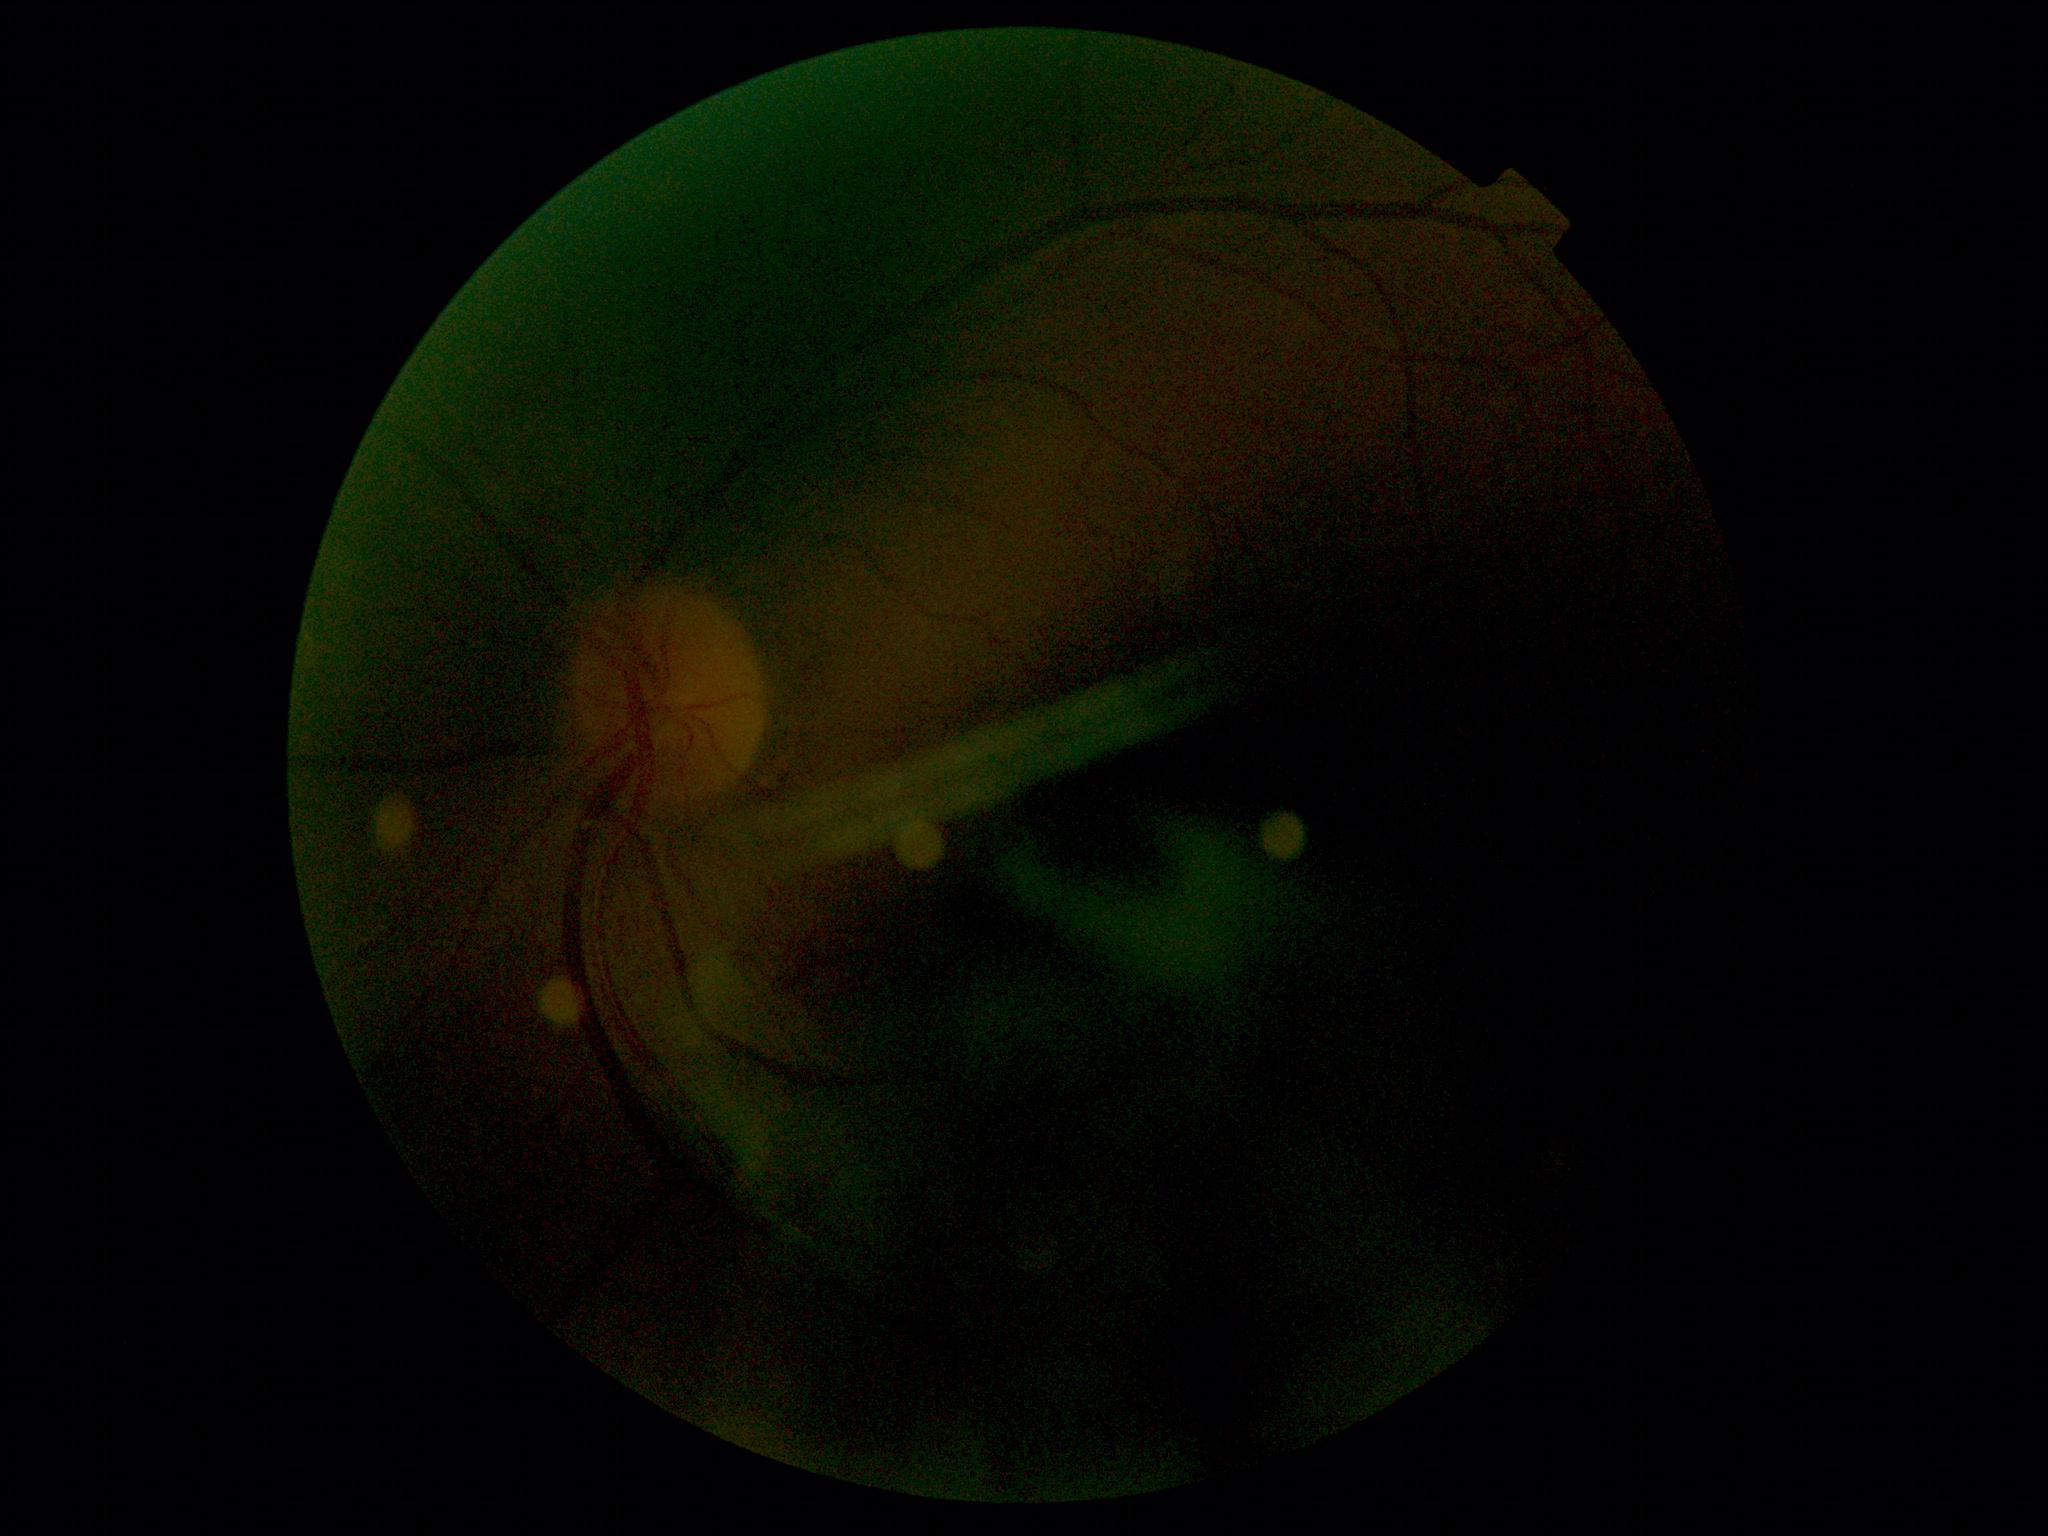

  dr_grade: ungradable